Portable fundus camera image; image size 2212x1659 — 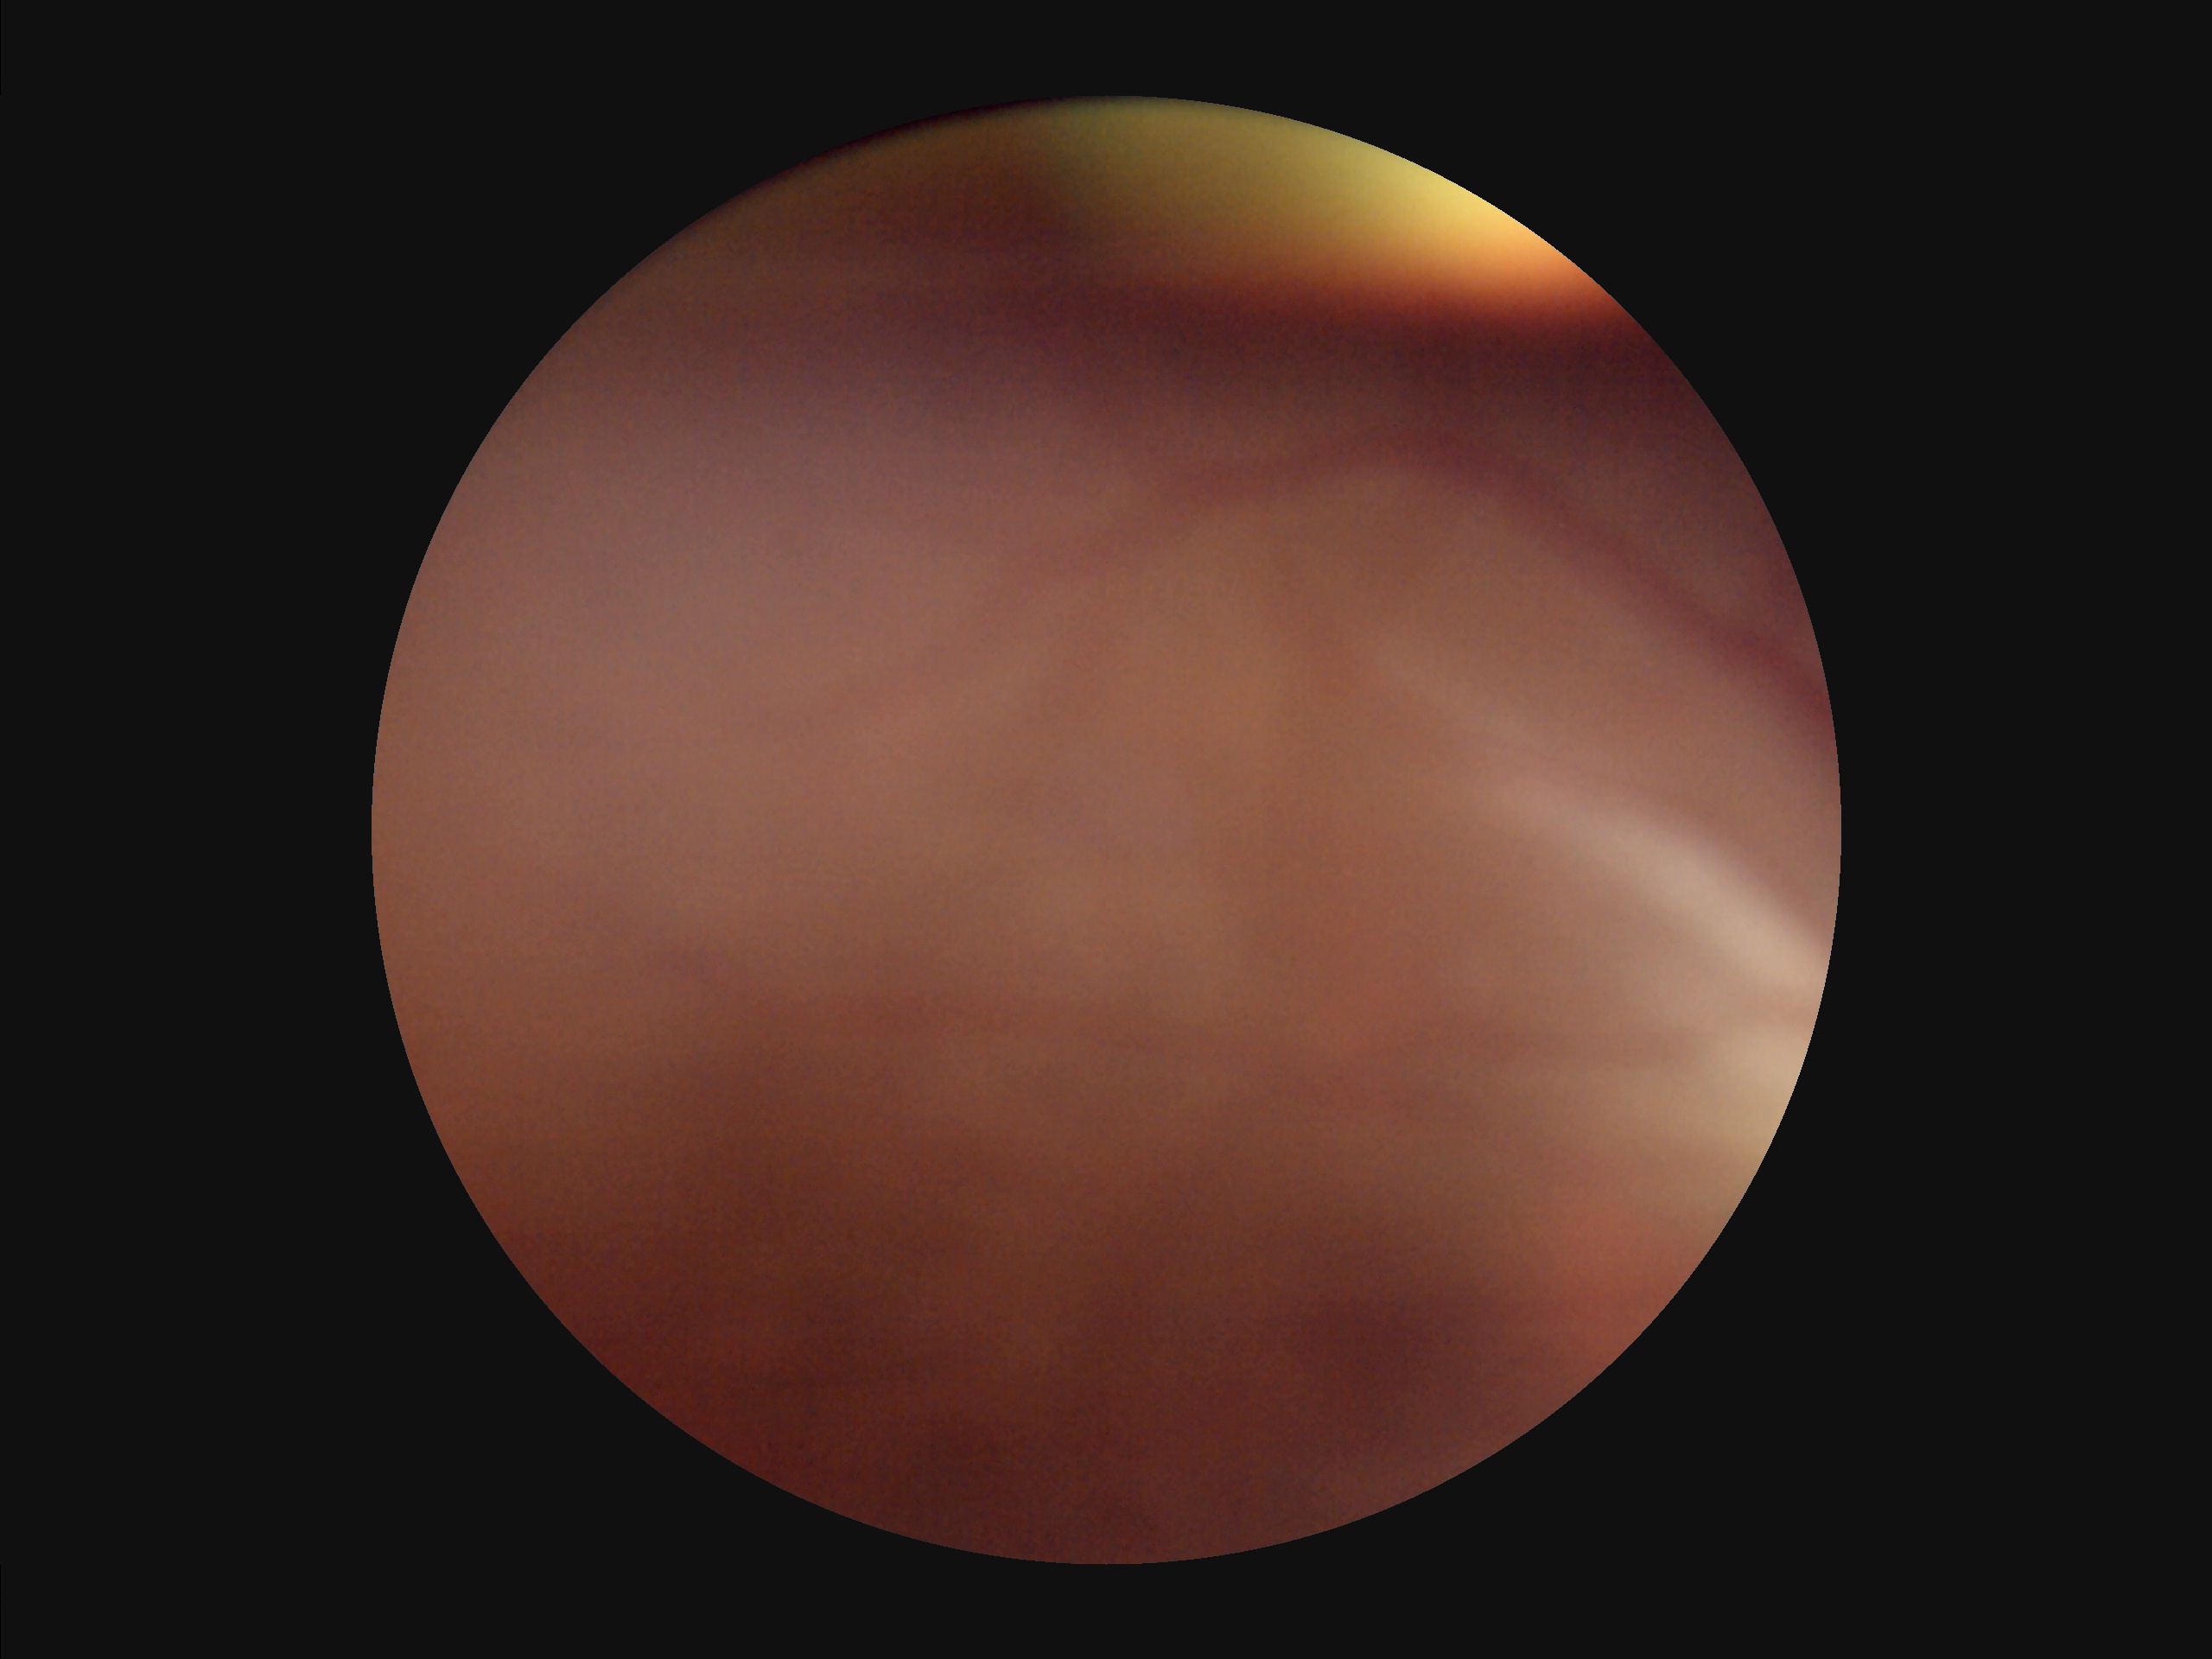 Poor dynamic range. Reduced sharpness with visible blur. Image quality is suboptimal. Illumination is uneven.